Wide-field fundus photograph of an infant — 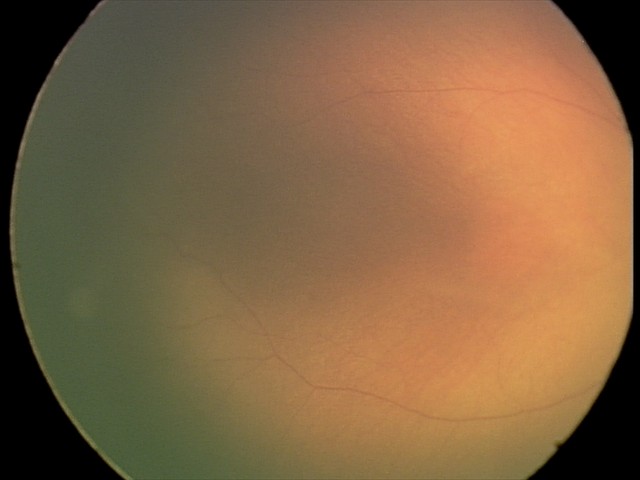 No retinal pathology identified on screening.